Acquired with a NIDEK AFC-230
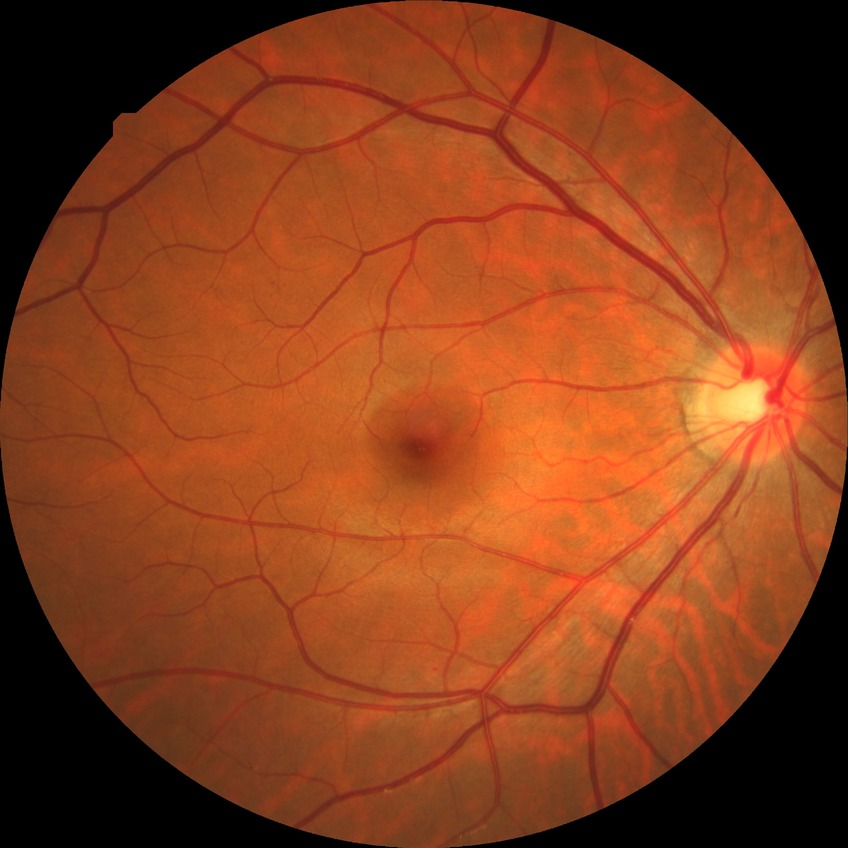 Modified Davis classification: simple diabetic retinopathy. DR class: non-proliferative diabetic retinopathy.